45° FOV; color fundus photograph; acquired with a NIDEK AFC-230; diabetic retinopathy graded by the modified Davis classification.
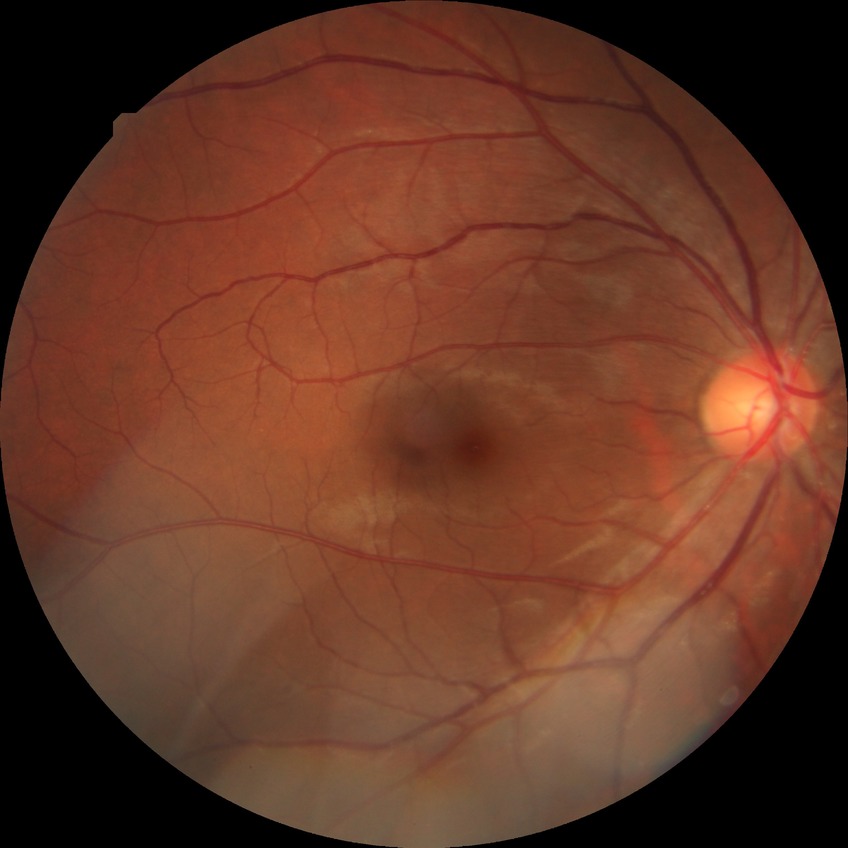

  davis_grade: no diabetic retinopathy (NDR)